Fundus photo — 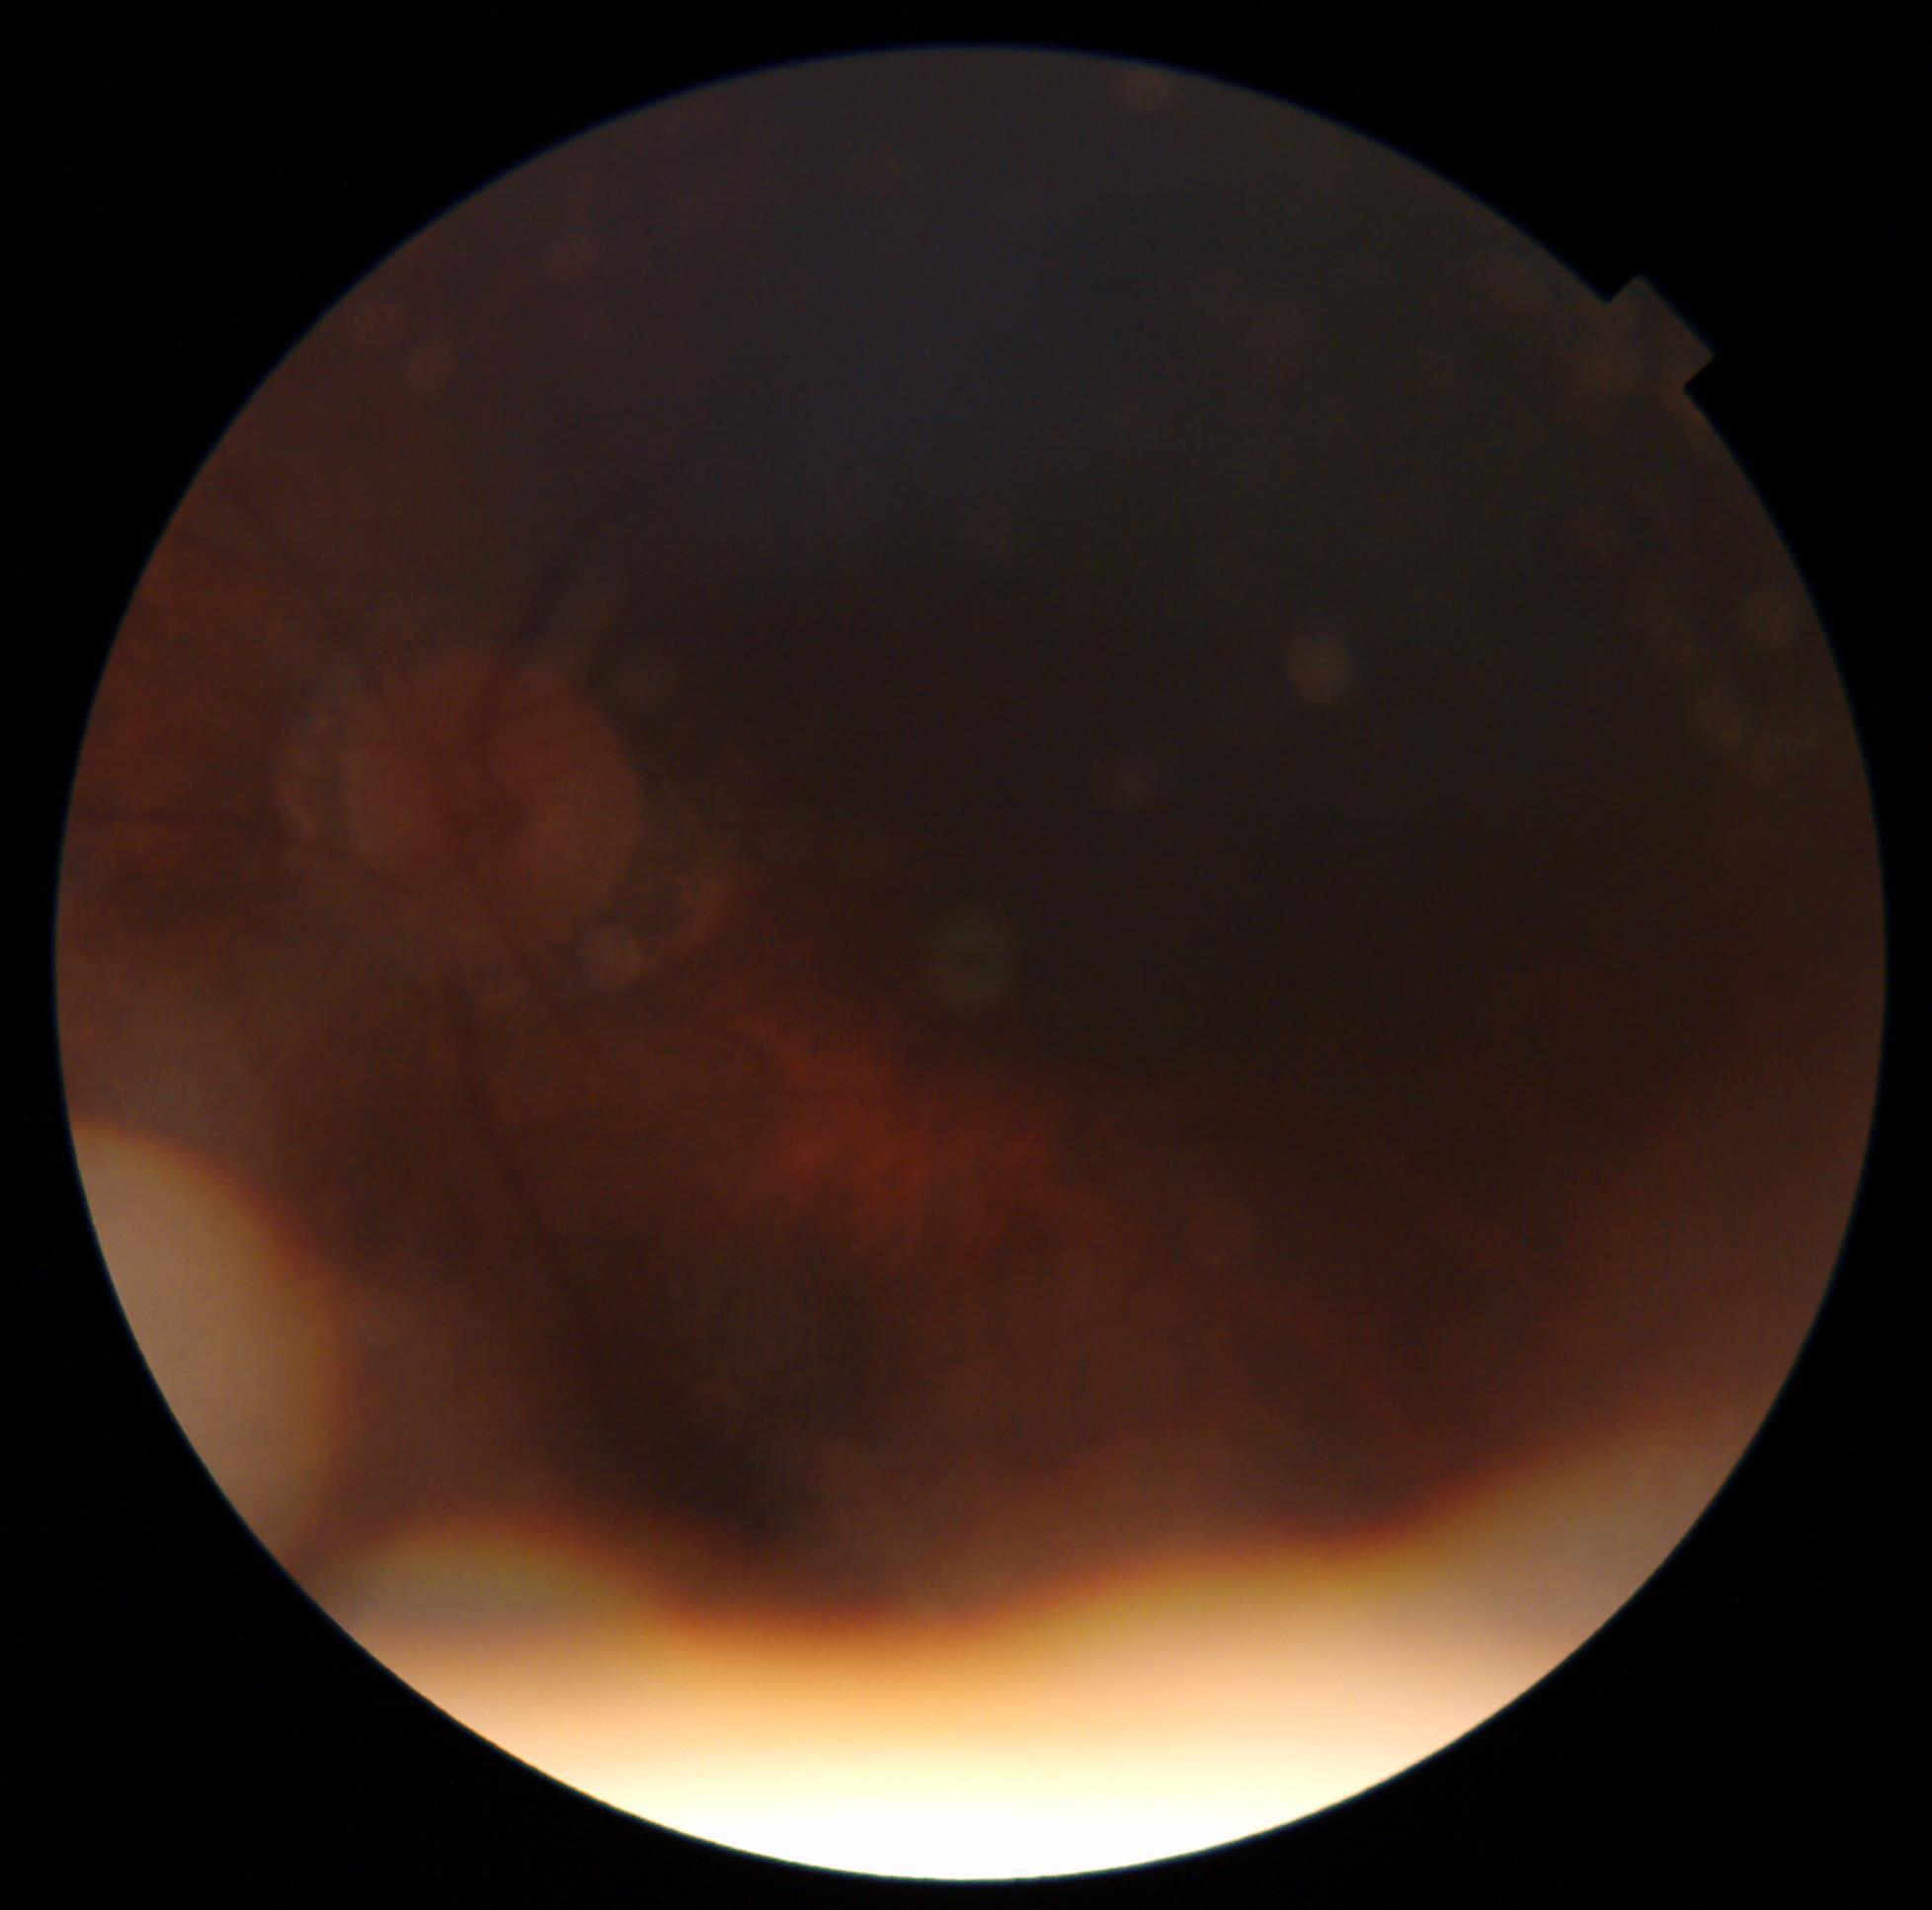

Findings:
- DR stage — ungradable
- image quality — insufficient